CFP:
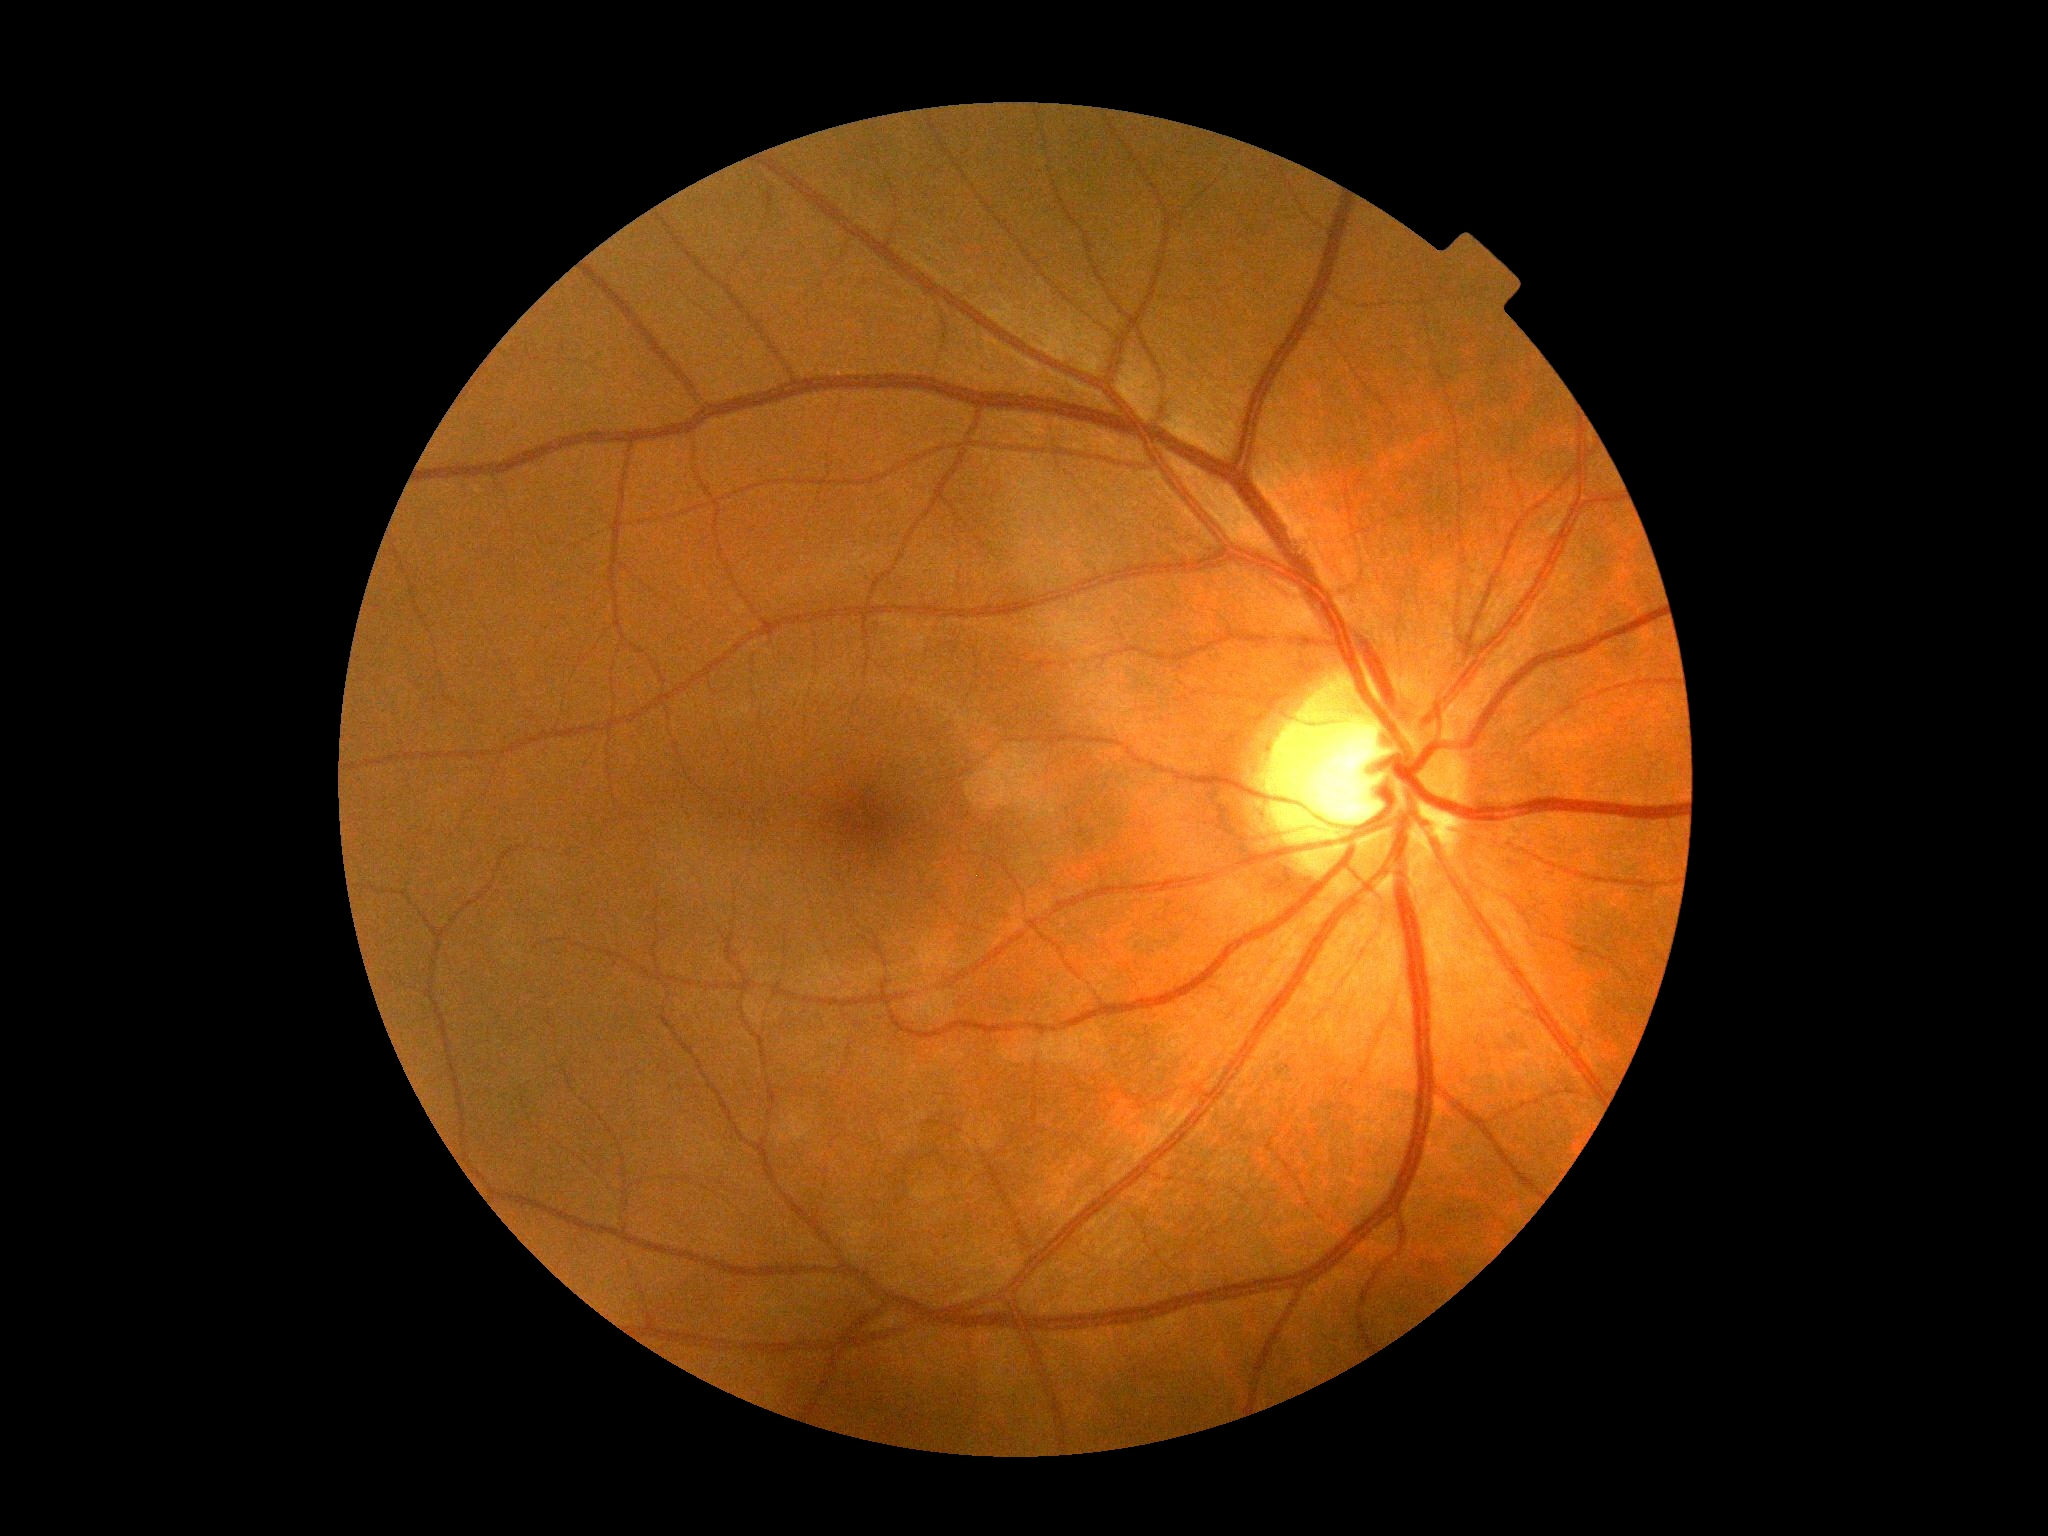 DR severity = no apparent retinopathy (grade 0), DR impression = negative for DR.